848 x 848 pixels; posterior pole color fundus photograph; no pharmacologic dilation; 45° field of view; camera: NIDEK AFC-230 — 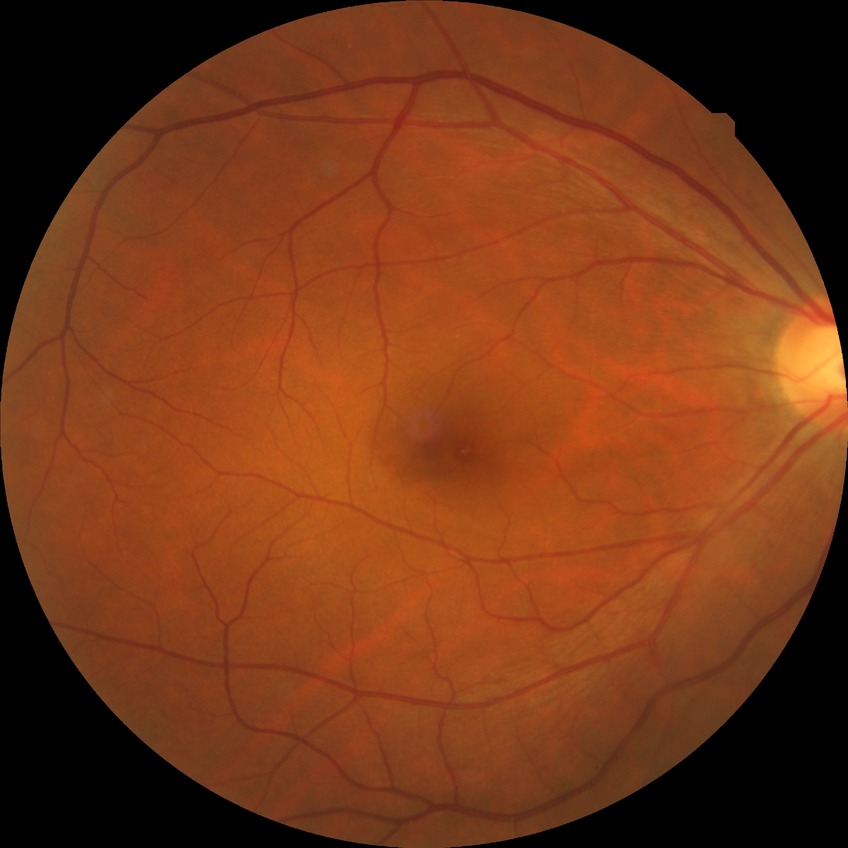

Diabetic retinopathy (DR) is no diabetic retinopathy (NDR).